1932 x 1916 pixels · CFP.
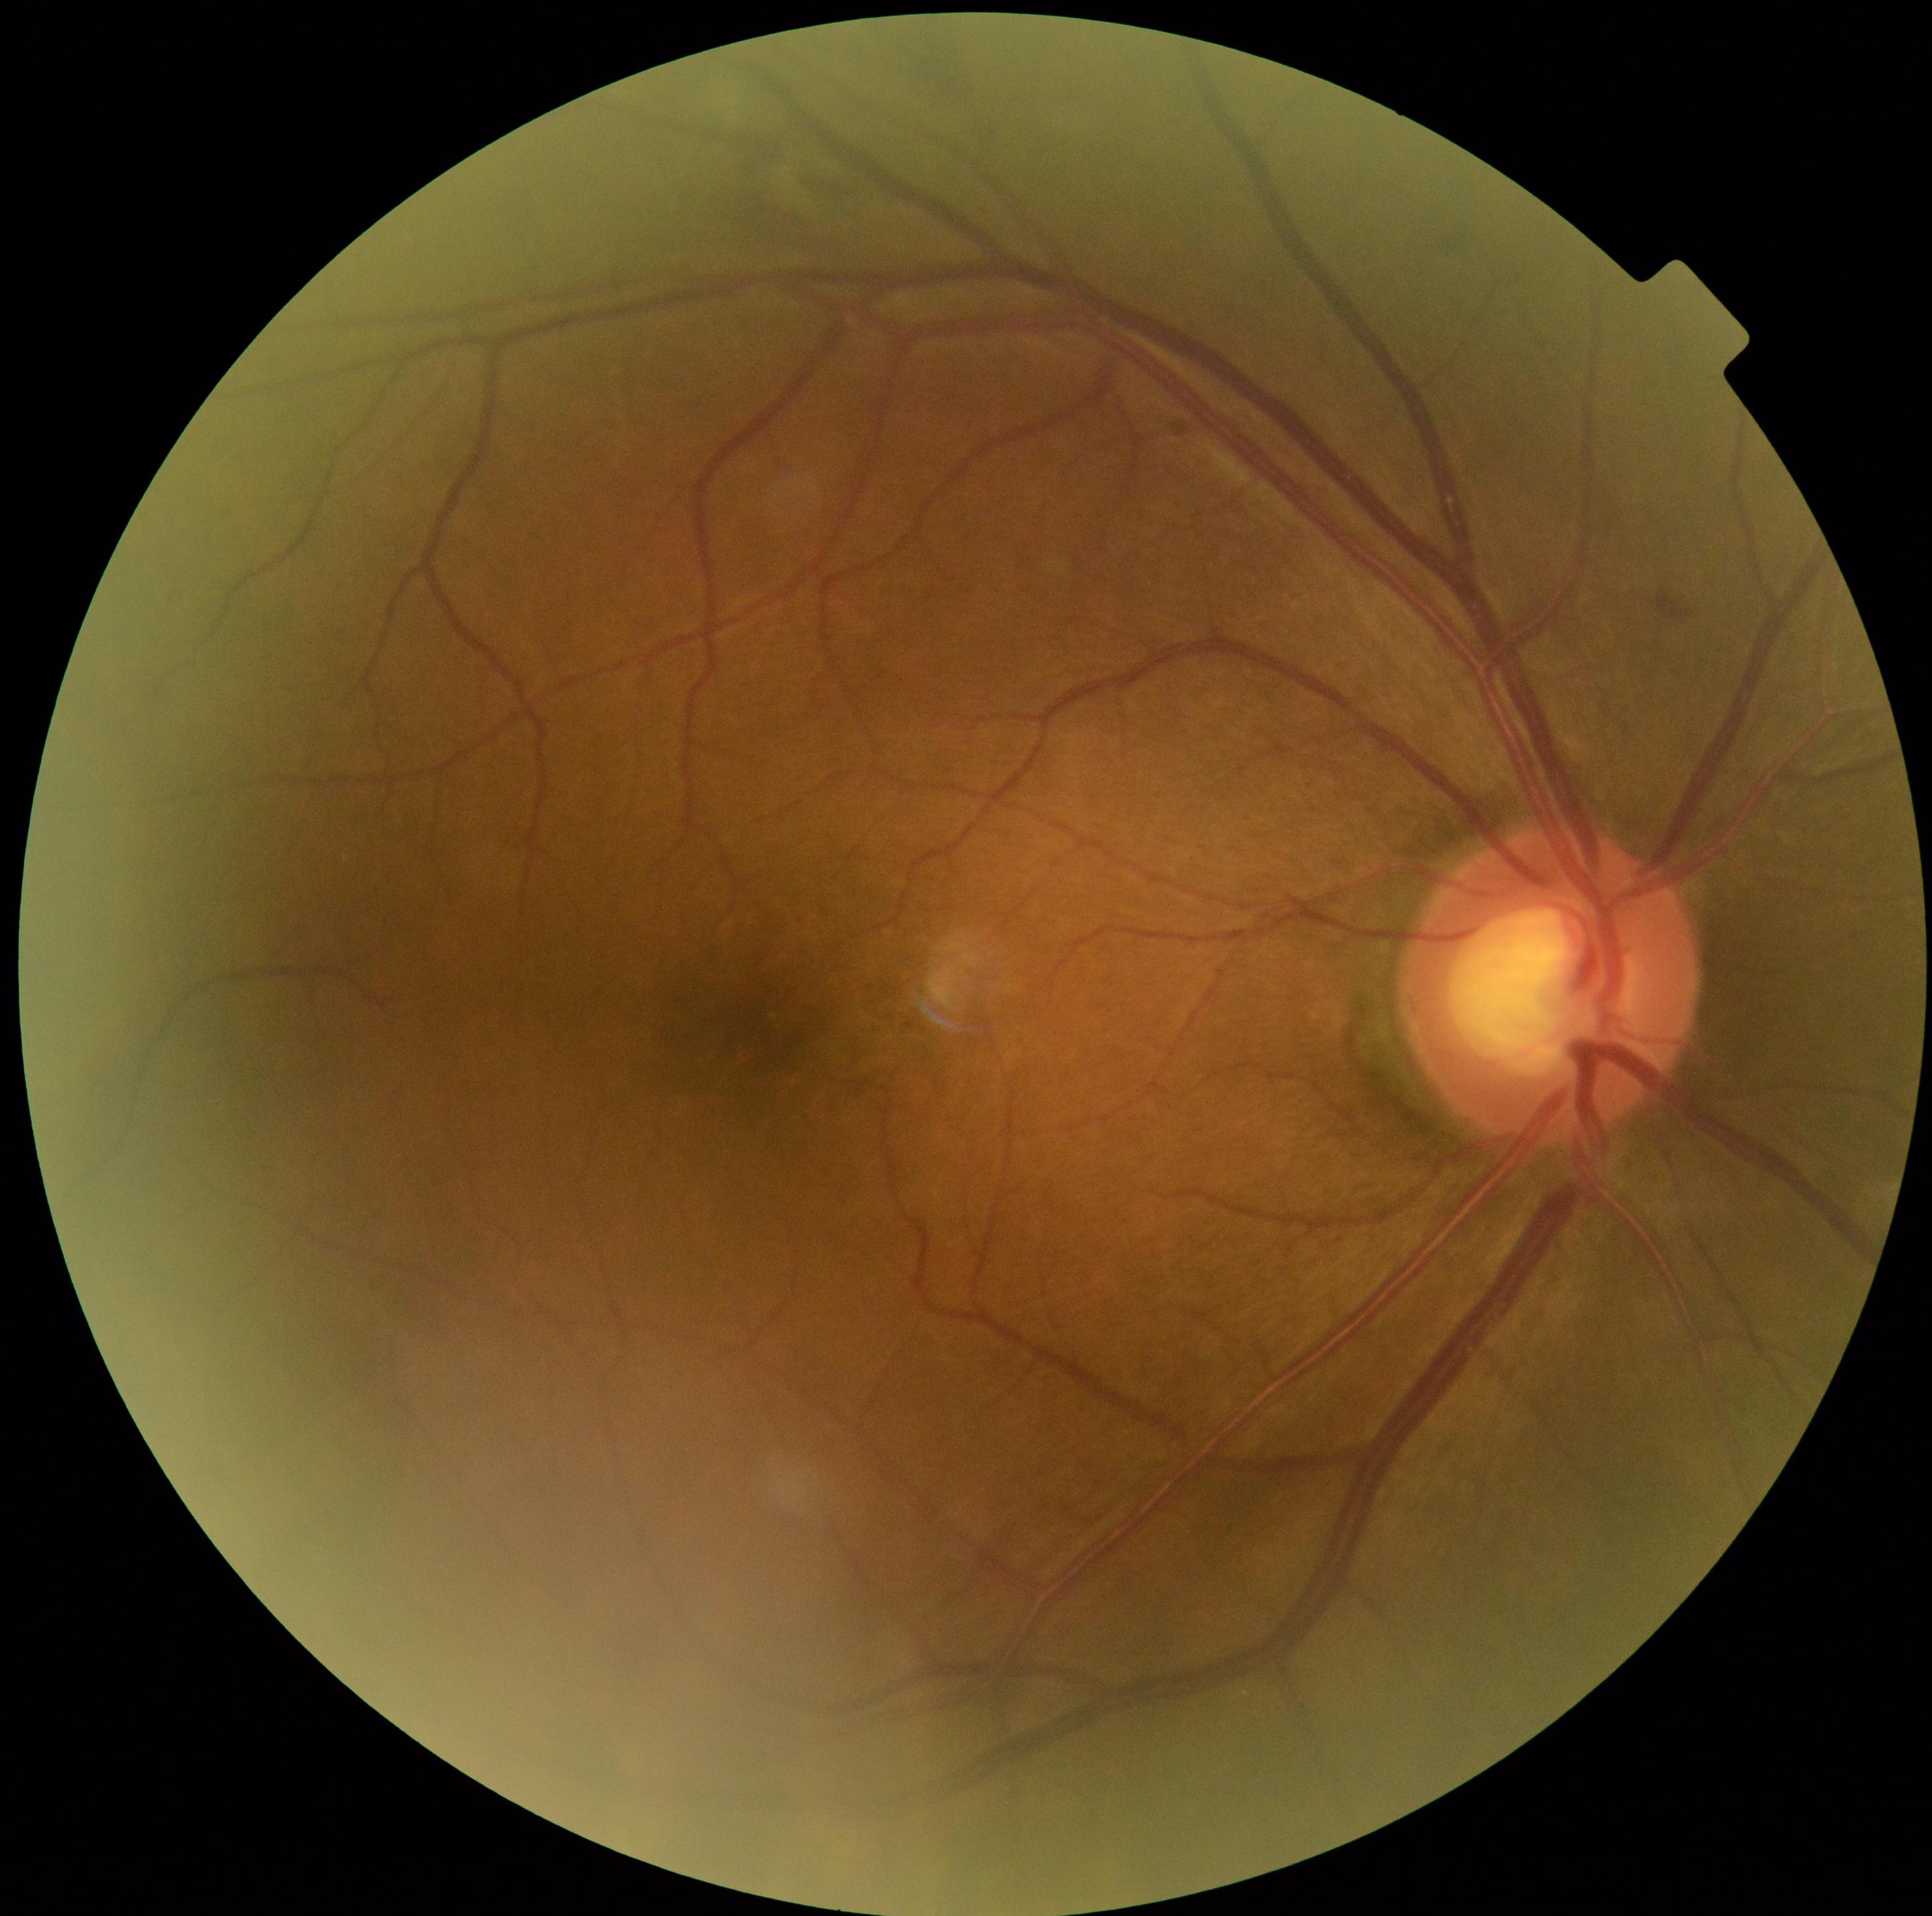 diabetic retinopathy grade=moderate non-proliferative diabetic retinopathy (2).